Modified Davis grading, NIDEK AFC-230 fundus camera, 848 by 848 pixels — 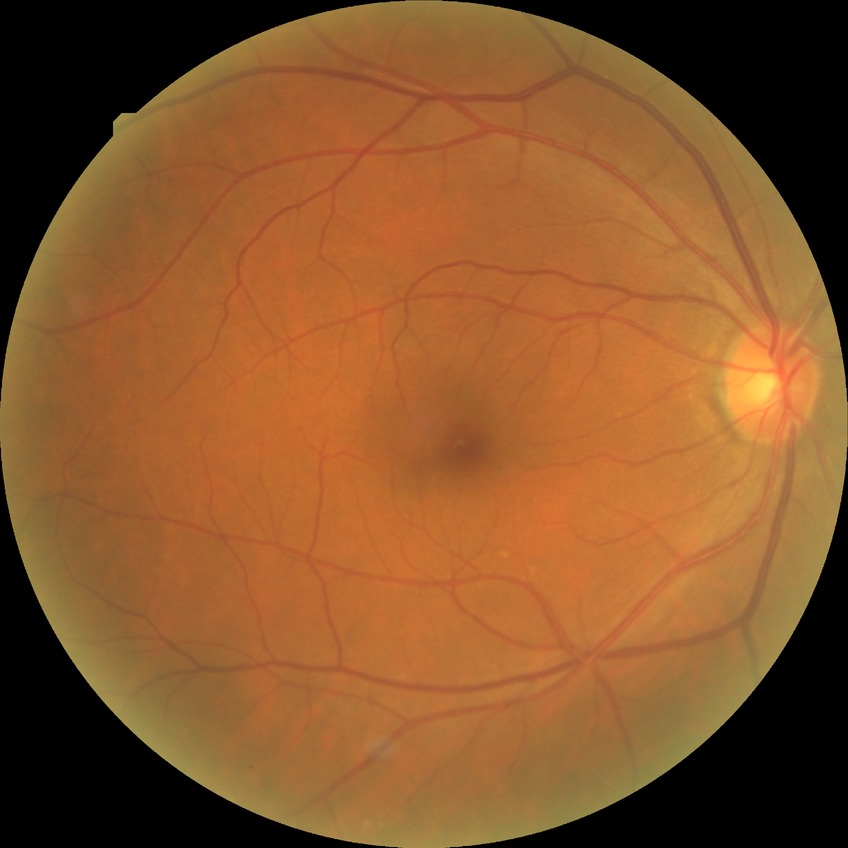 {
  "davis_grade": "NDR (no diabetic retinopathy)"
}